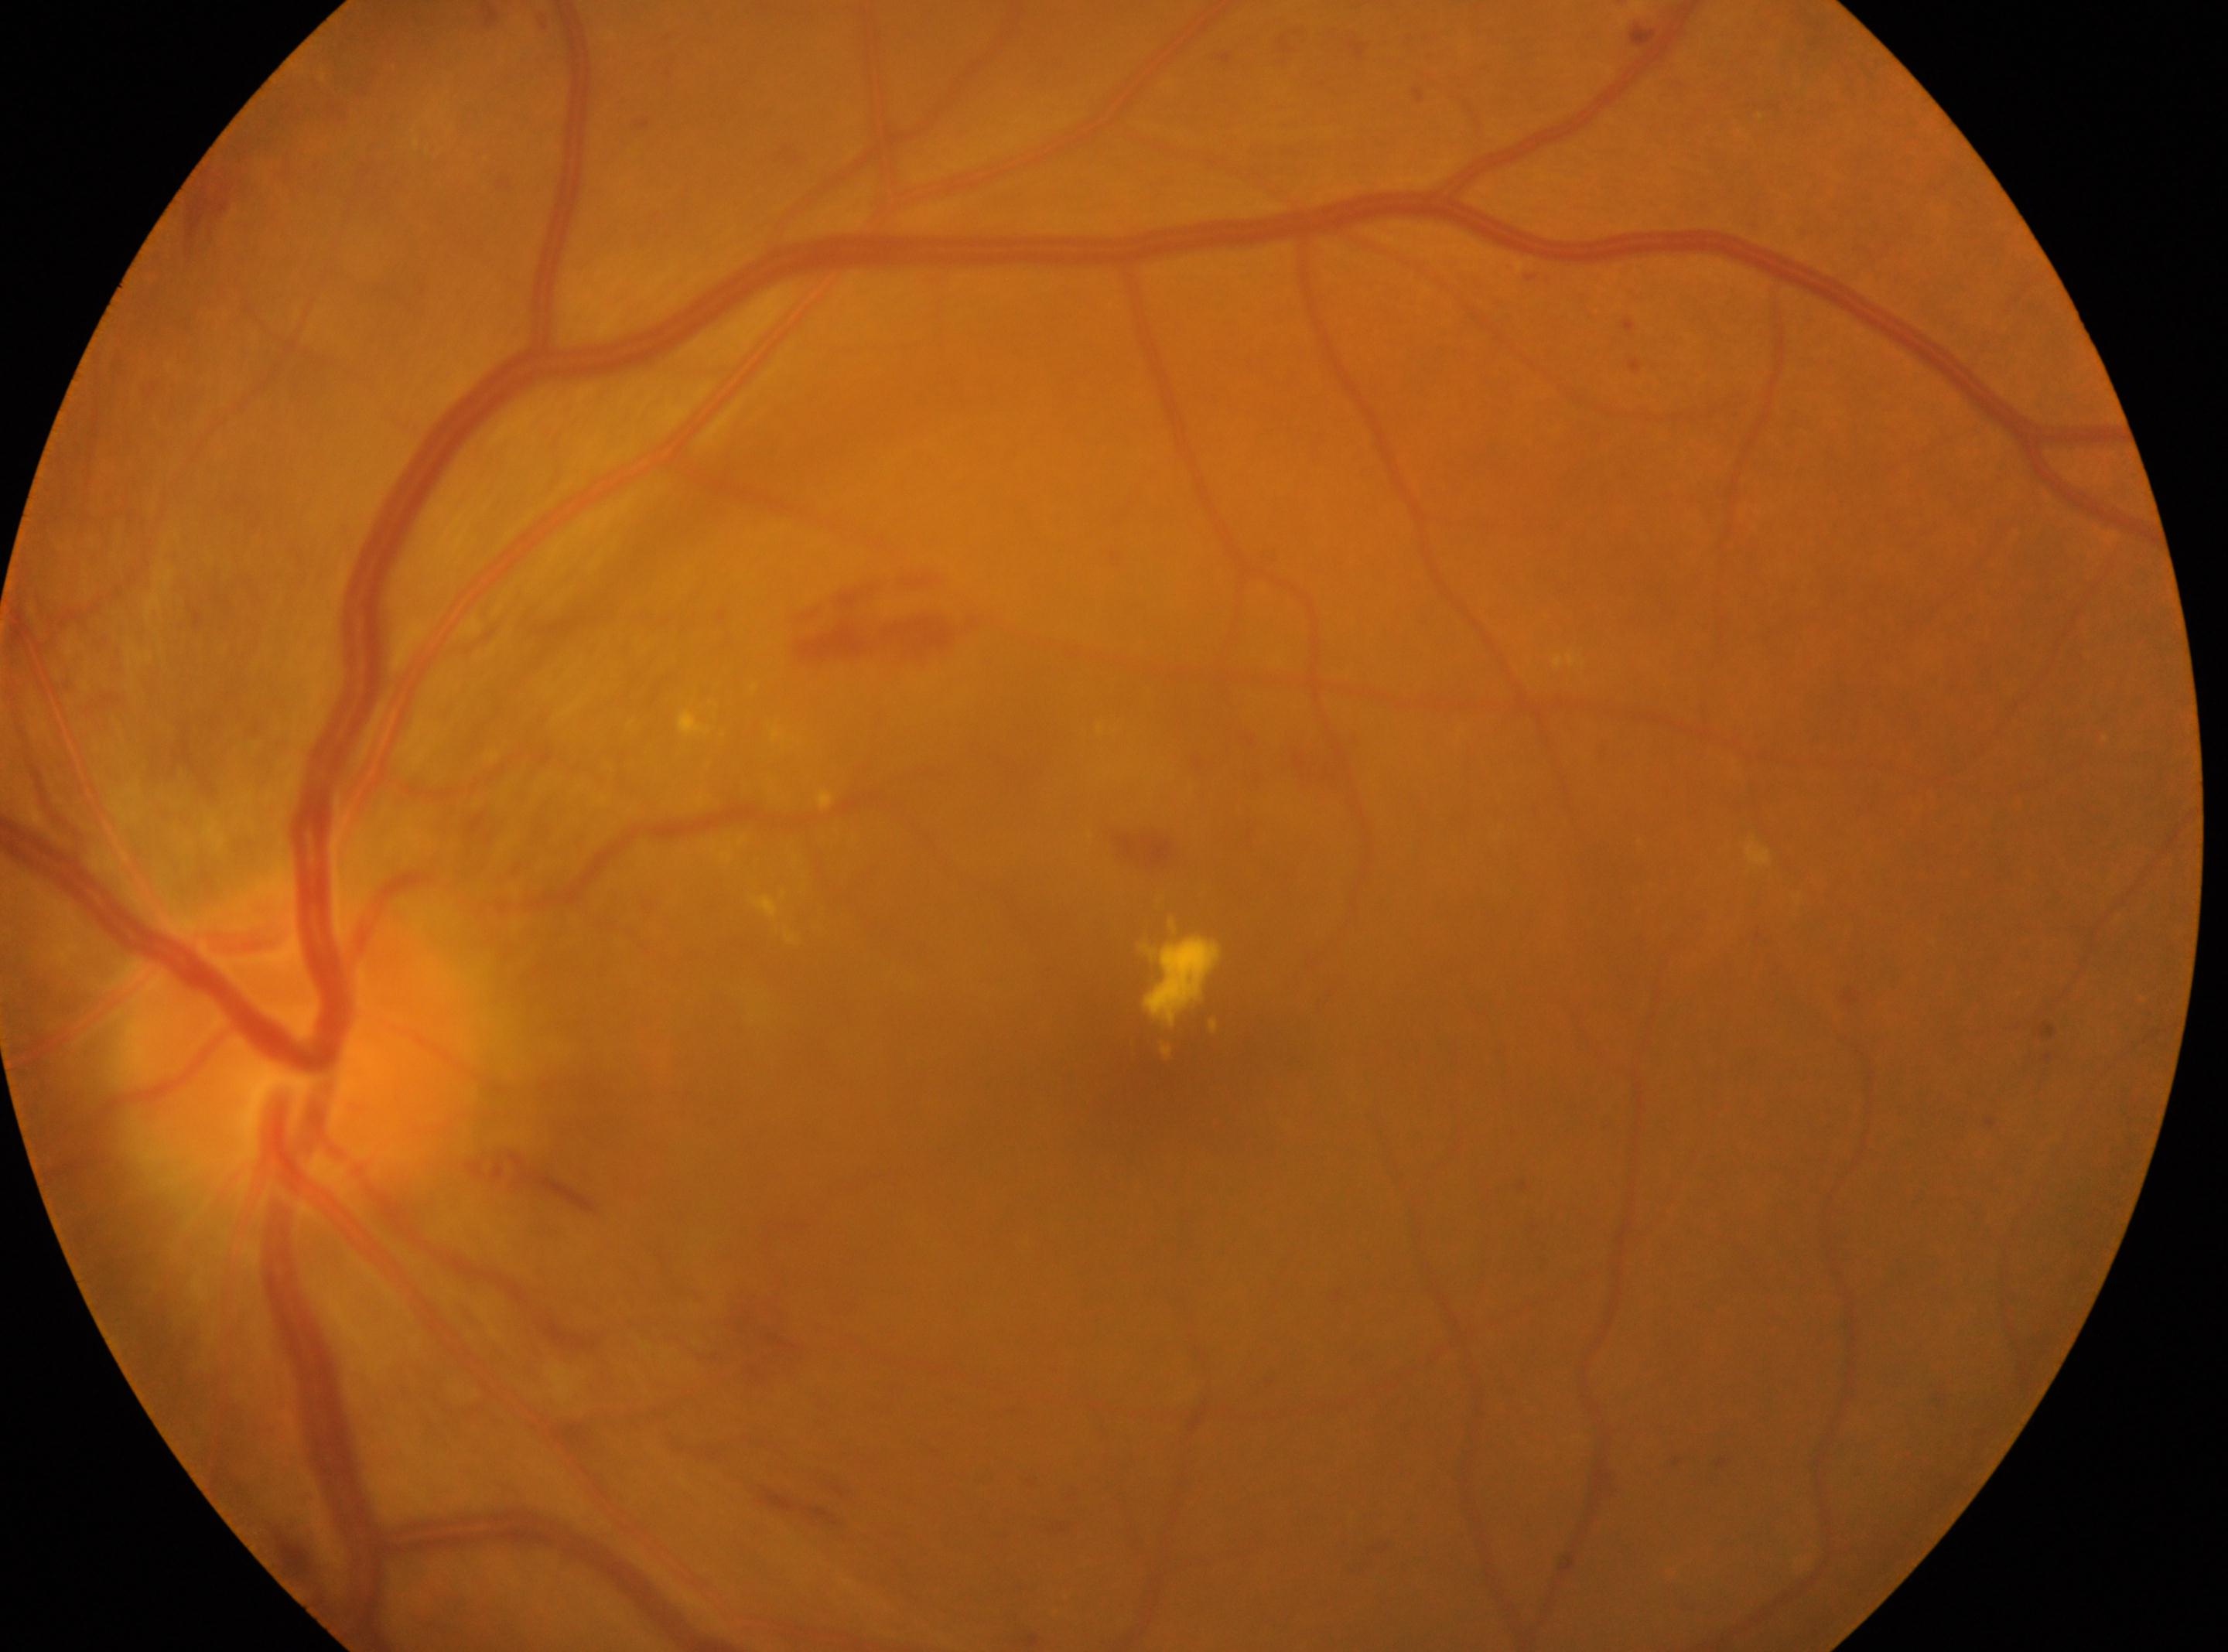 DR is grade 2.
ONH located at (x: 300, y: 1055).
This is the left eye.
The macular center is at (x: 1164, y: 1103).